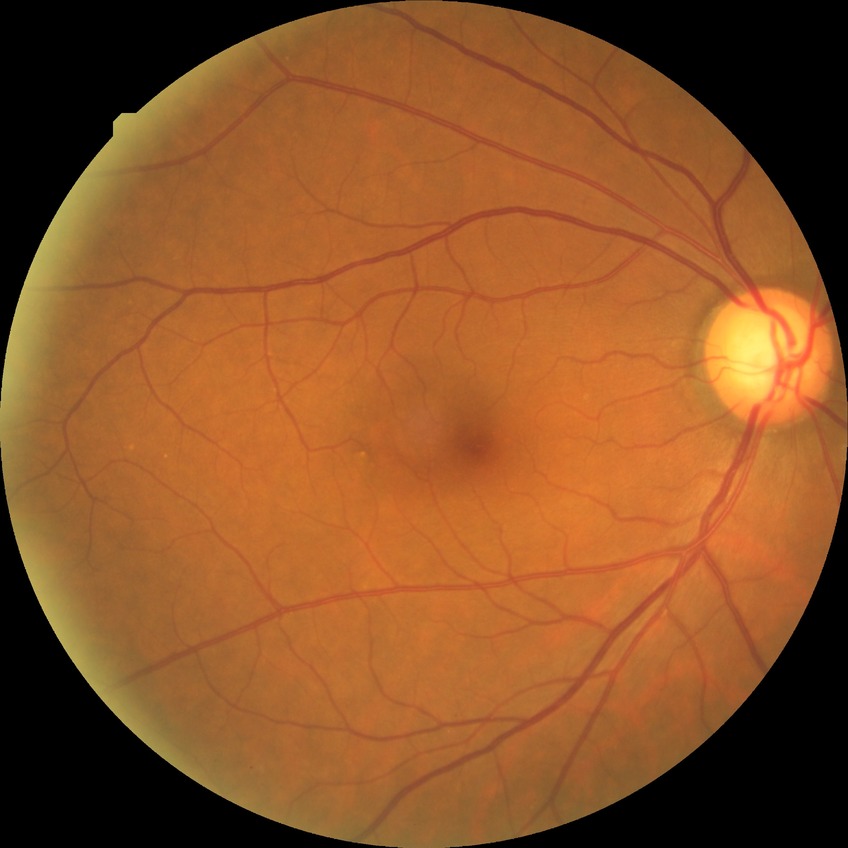 Retinopathy grade is no diabetic retinopathy.